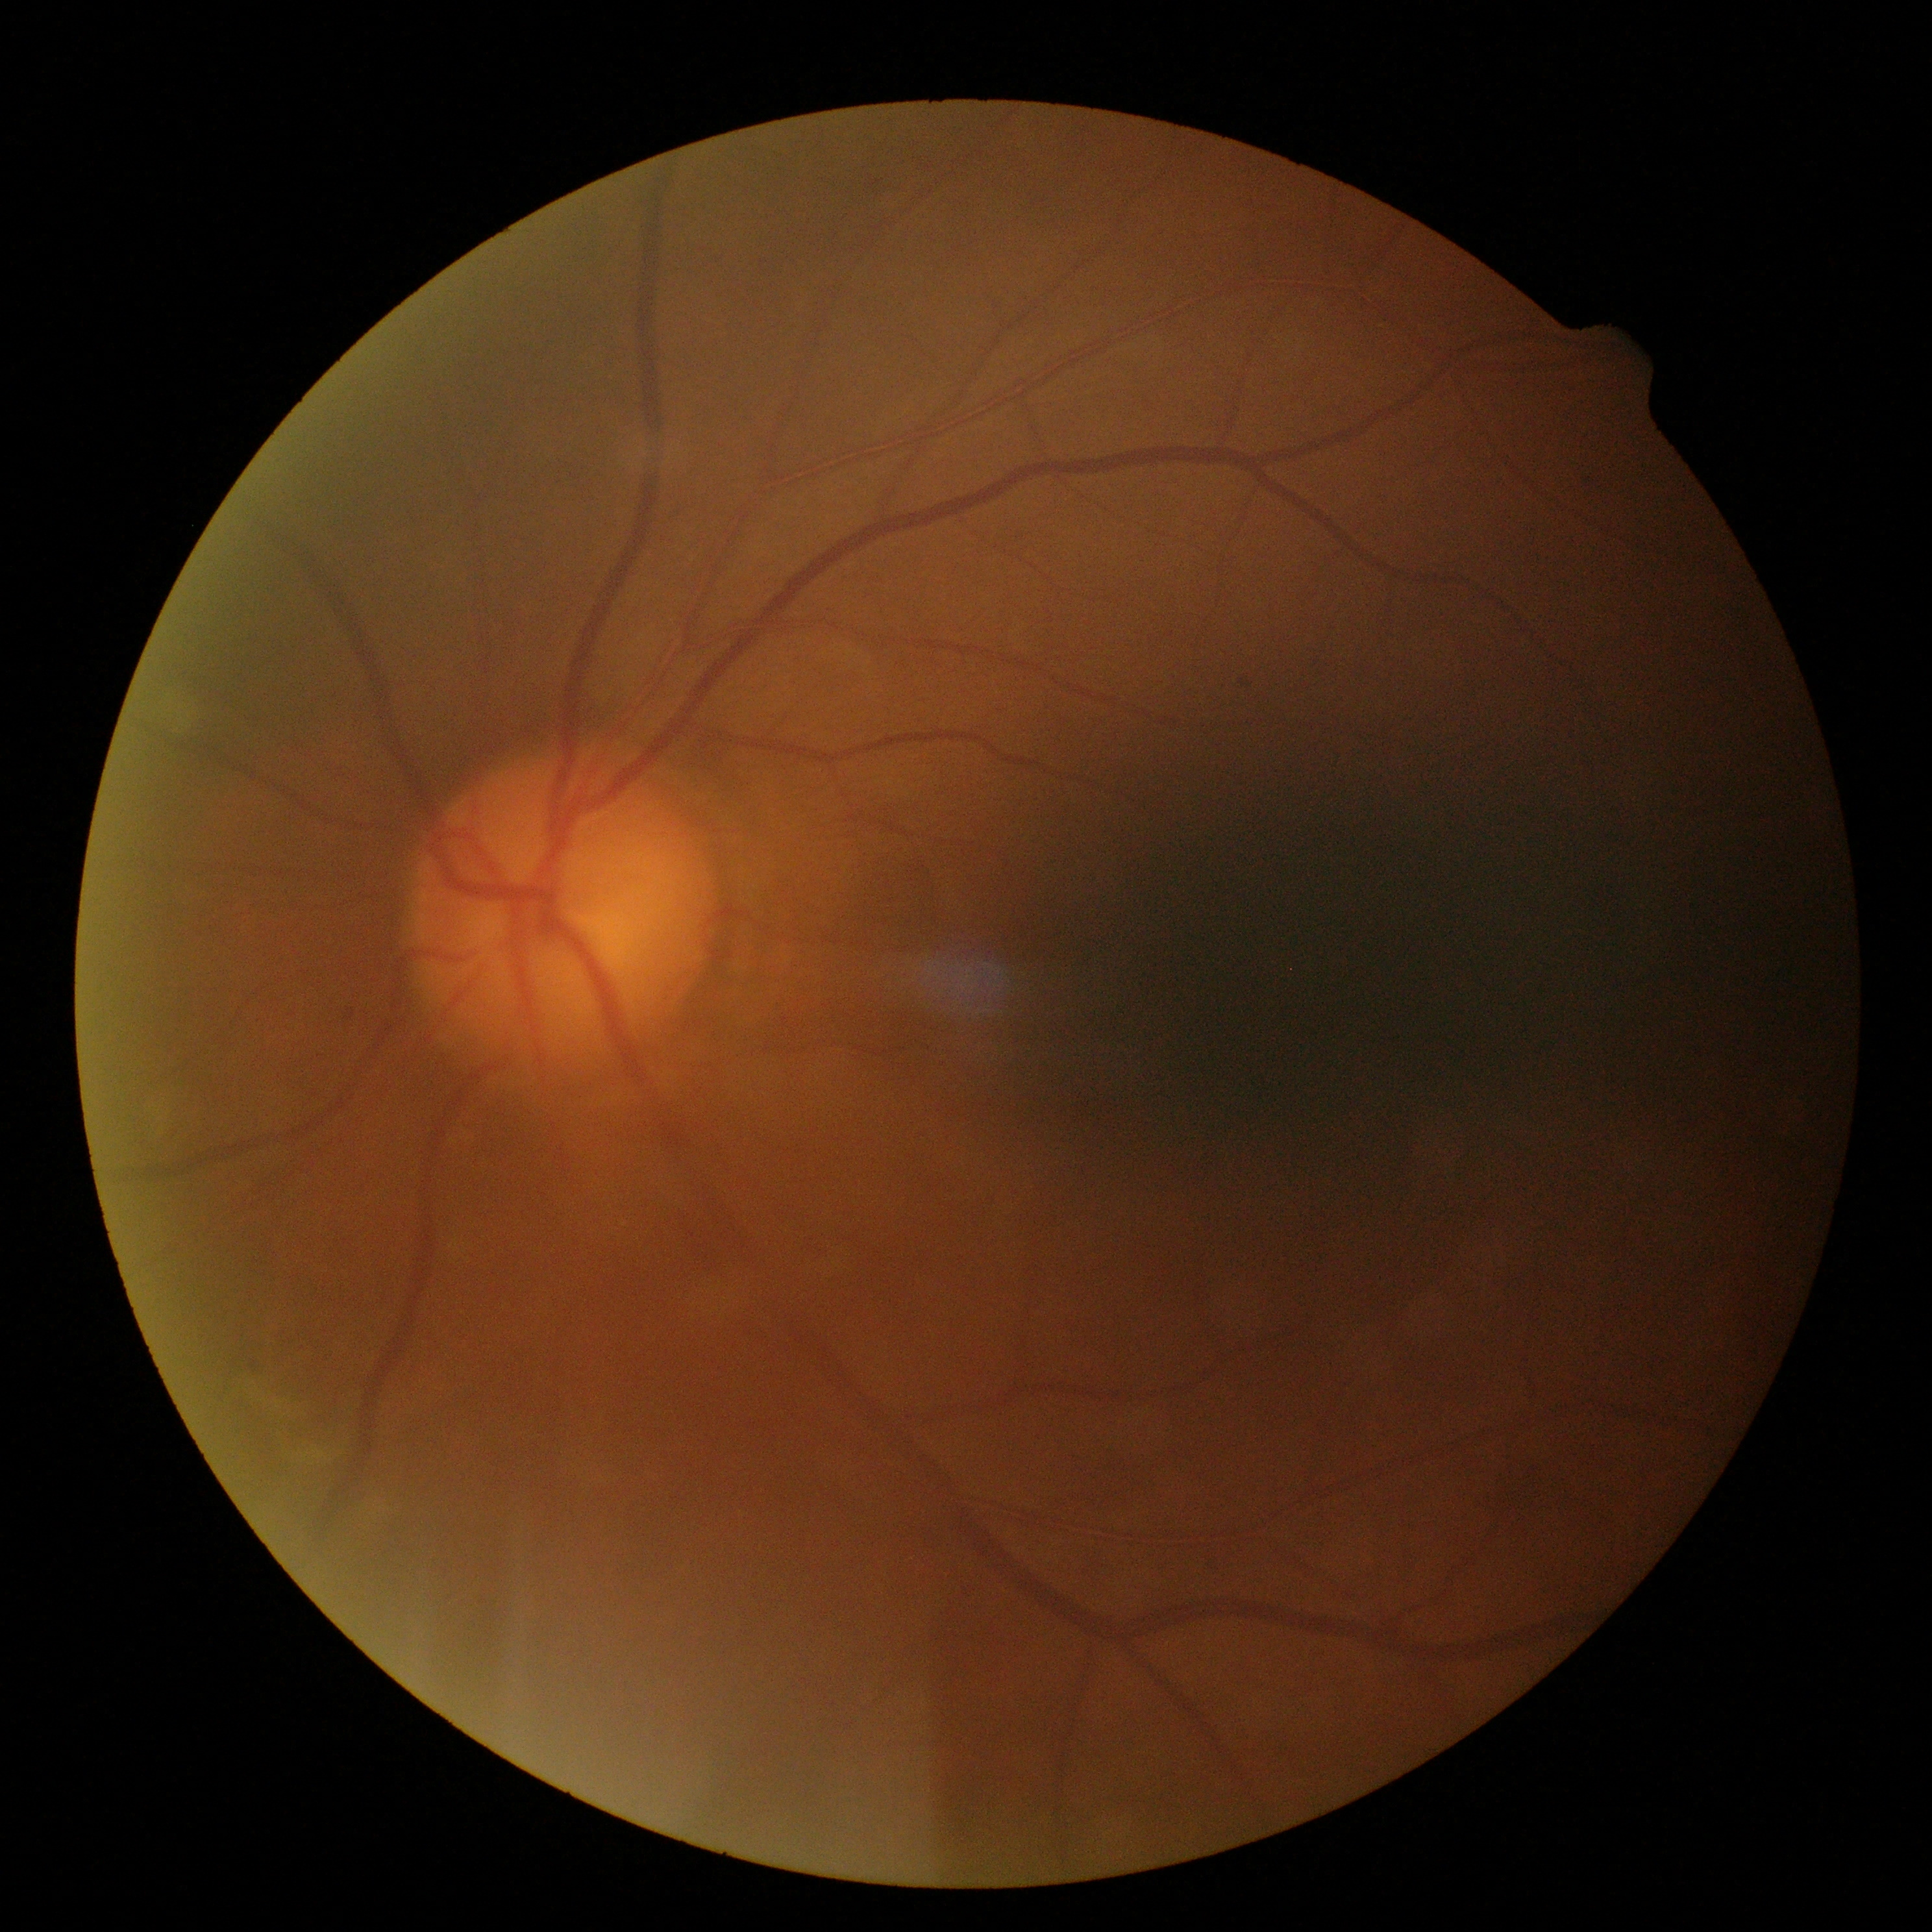

Diabetic retinopathy (DR) is grade 2 (moderate NPDR).